45° field of view:
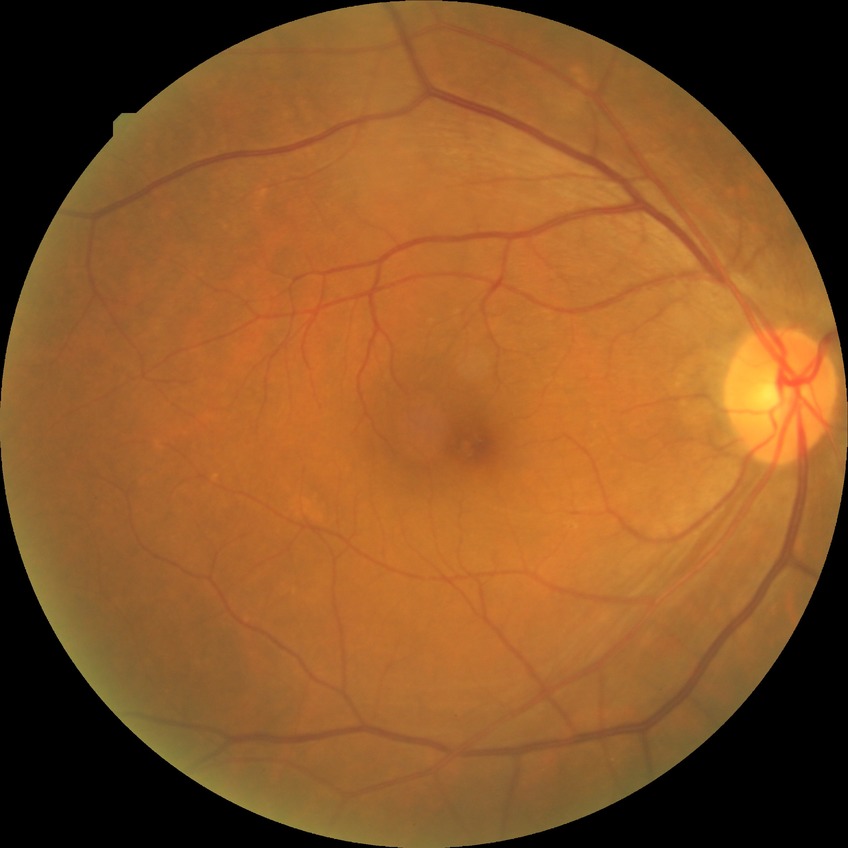 Diabetic retinopathy stage: no diabetic retinopathy.